45 degree fundus photograph; posterior pole color fundus photograph; image size 848x848; no pharmacologic dilation
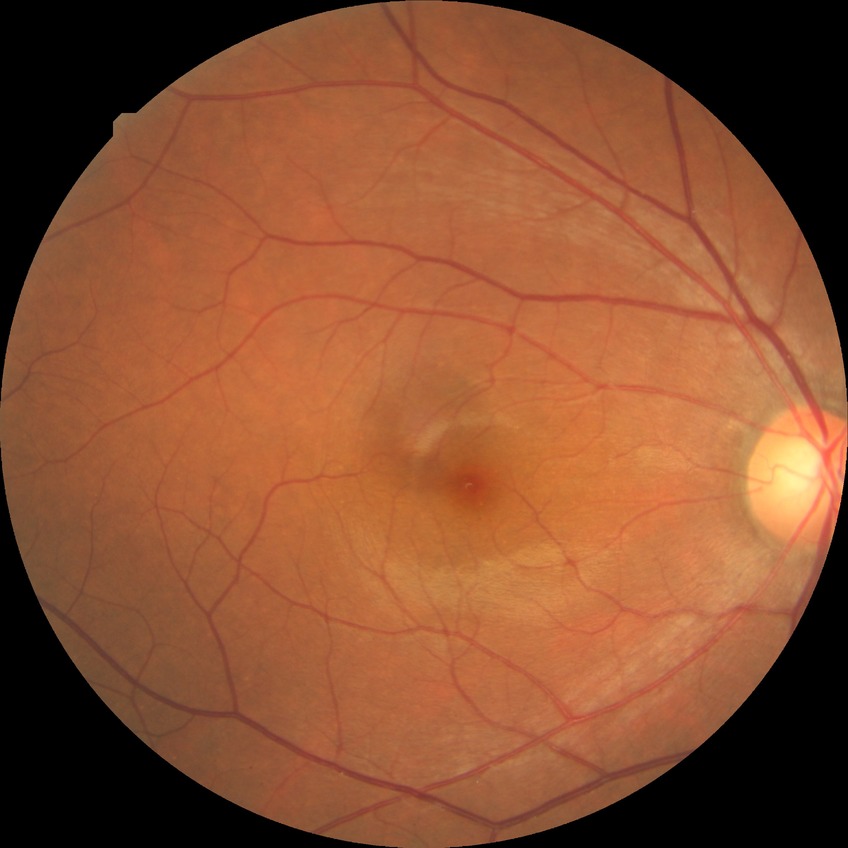
Diabetic retinopathy (DR): NDR (no diabetic retinopathy).